Davis DR grading. Camera: NIDEK AFC-230:
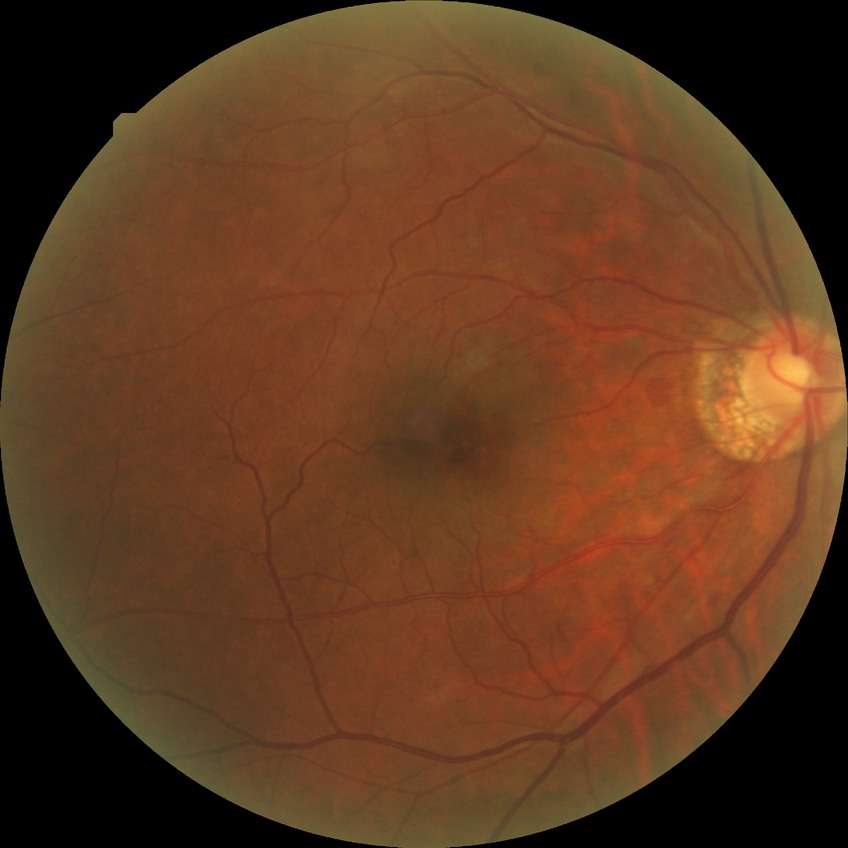 davis_grade: PPDR (pre-proliferative diabetic retinopathy)
proliferative_class: non-proliferative diabetic retinopathy